Image size 2352x1568. 45° field of view. Color fundus photograph: 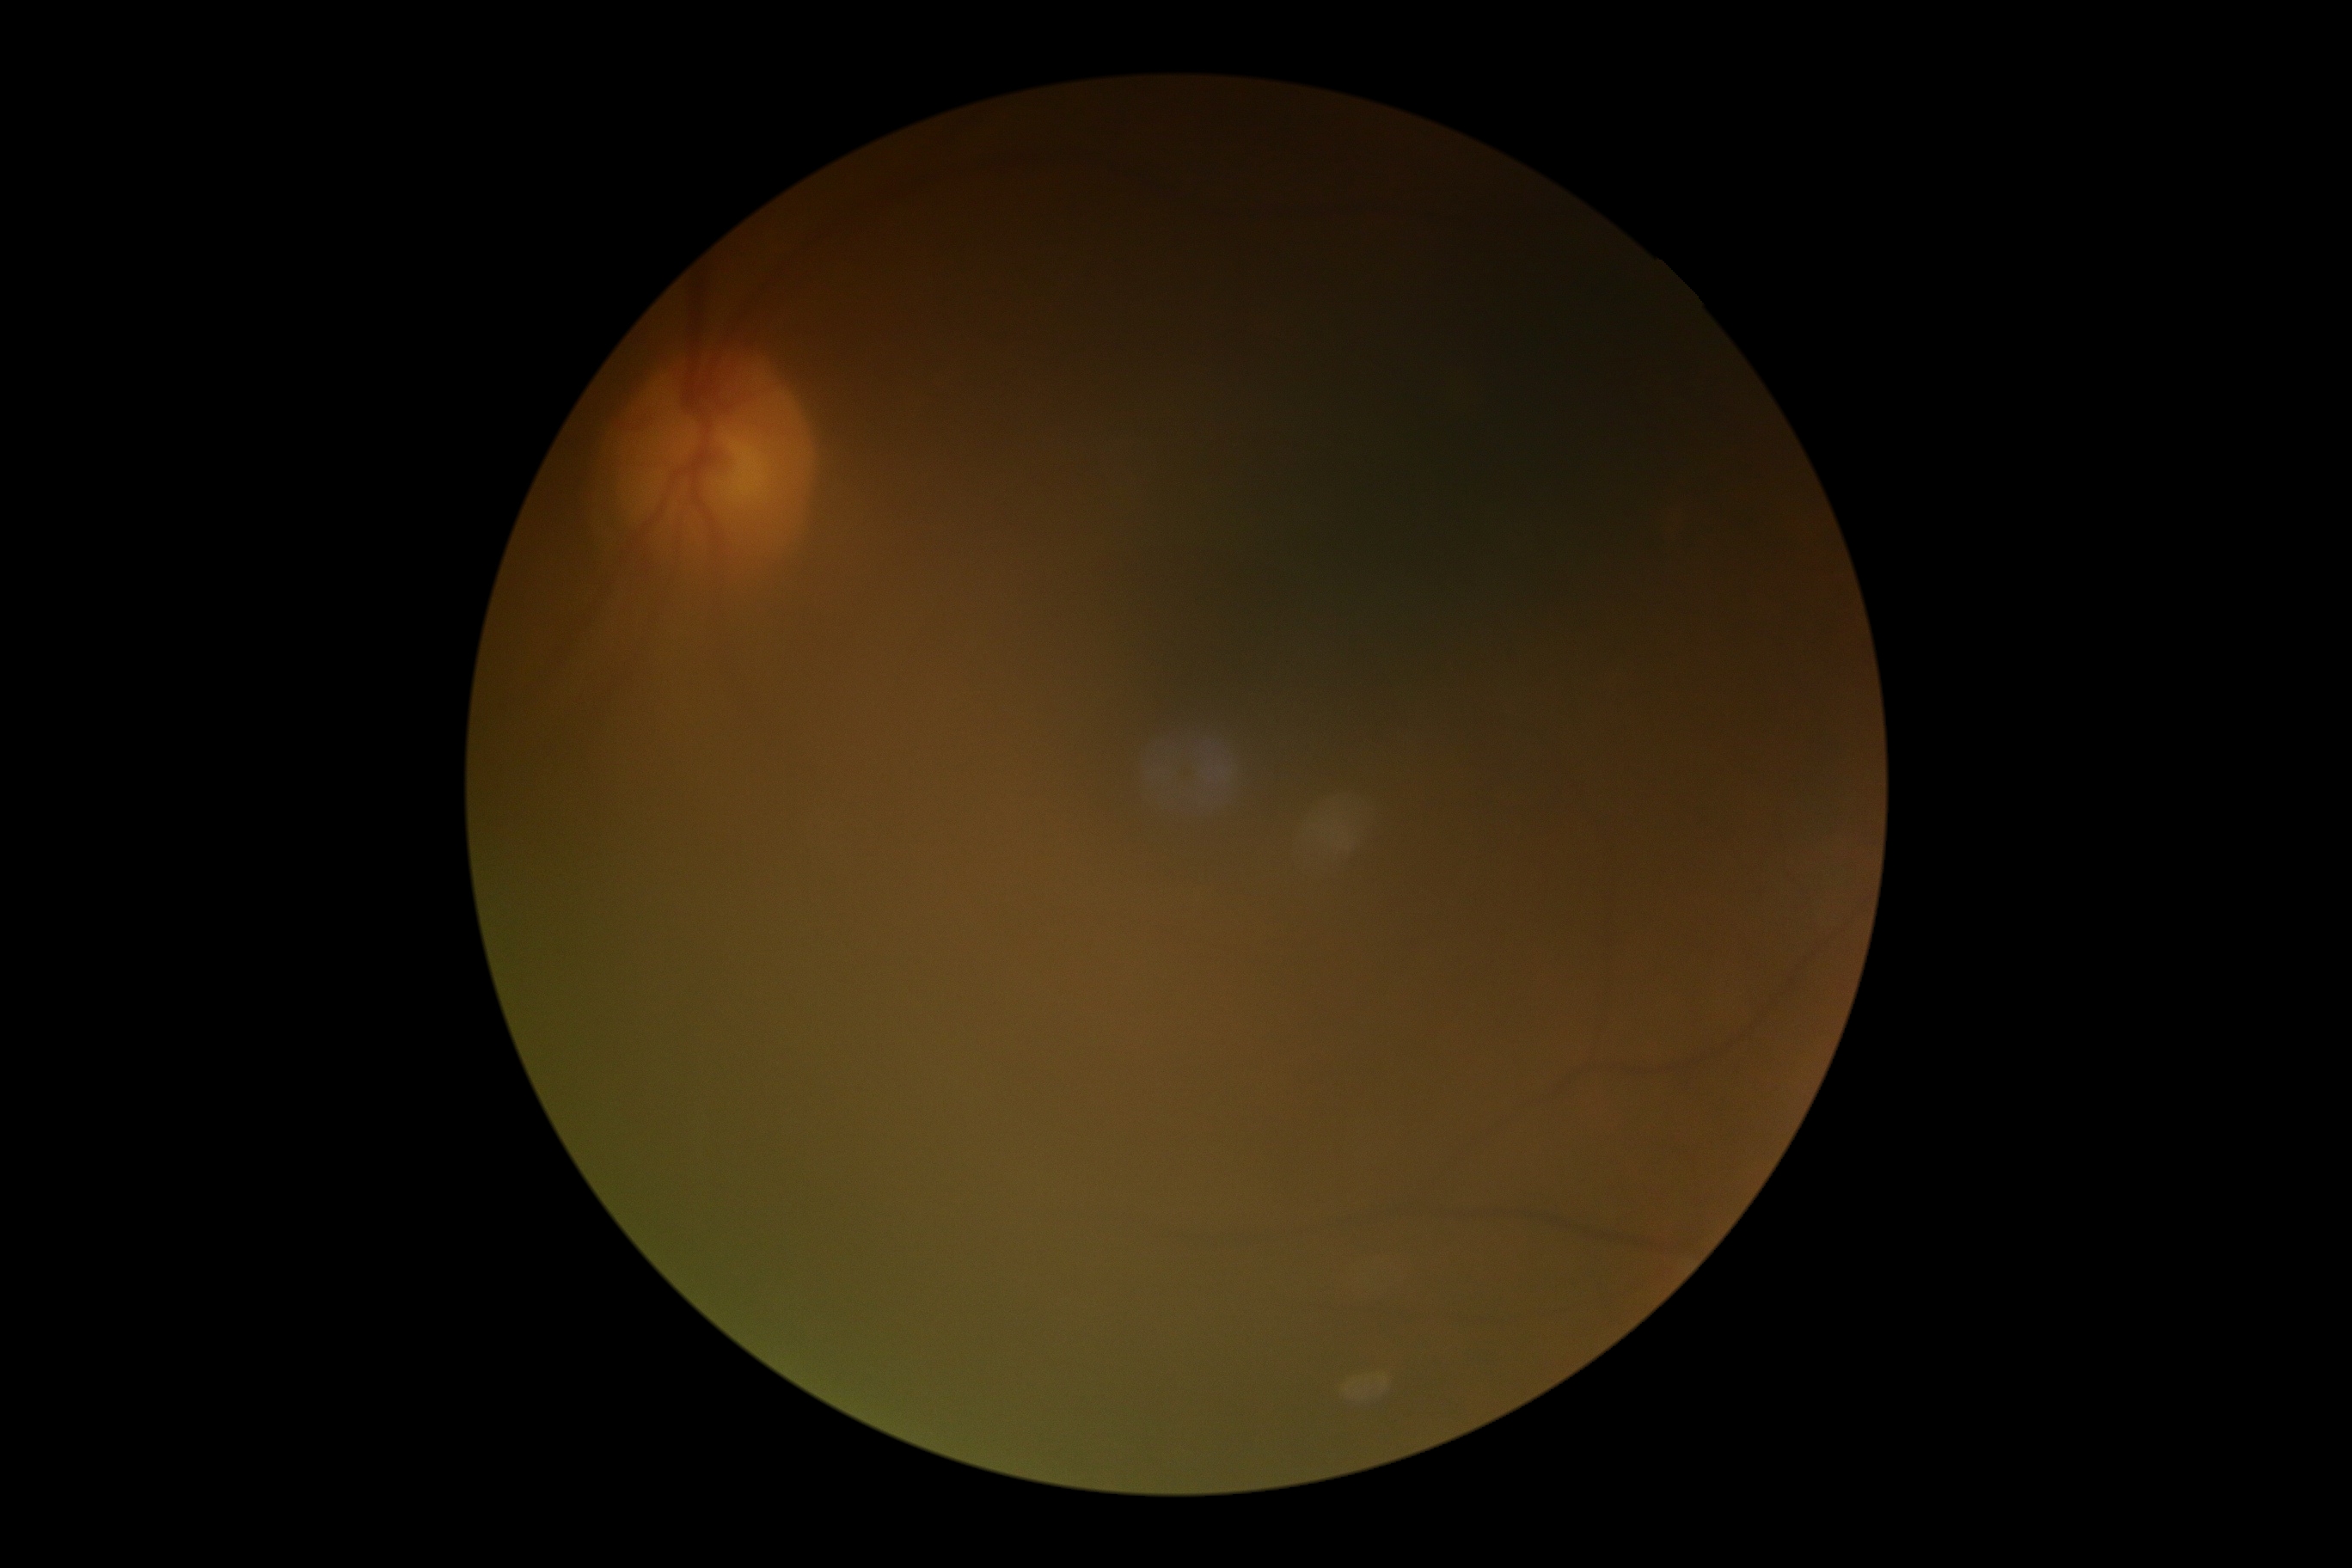 Diabetic retinopathy severity is ungradable due to poor image quality.